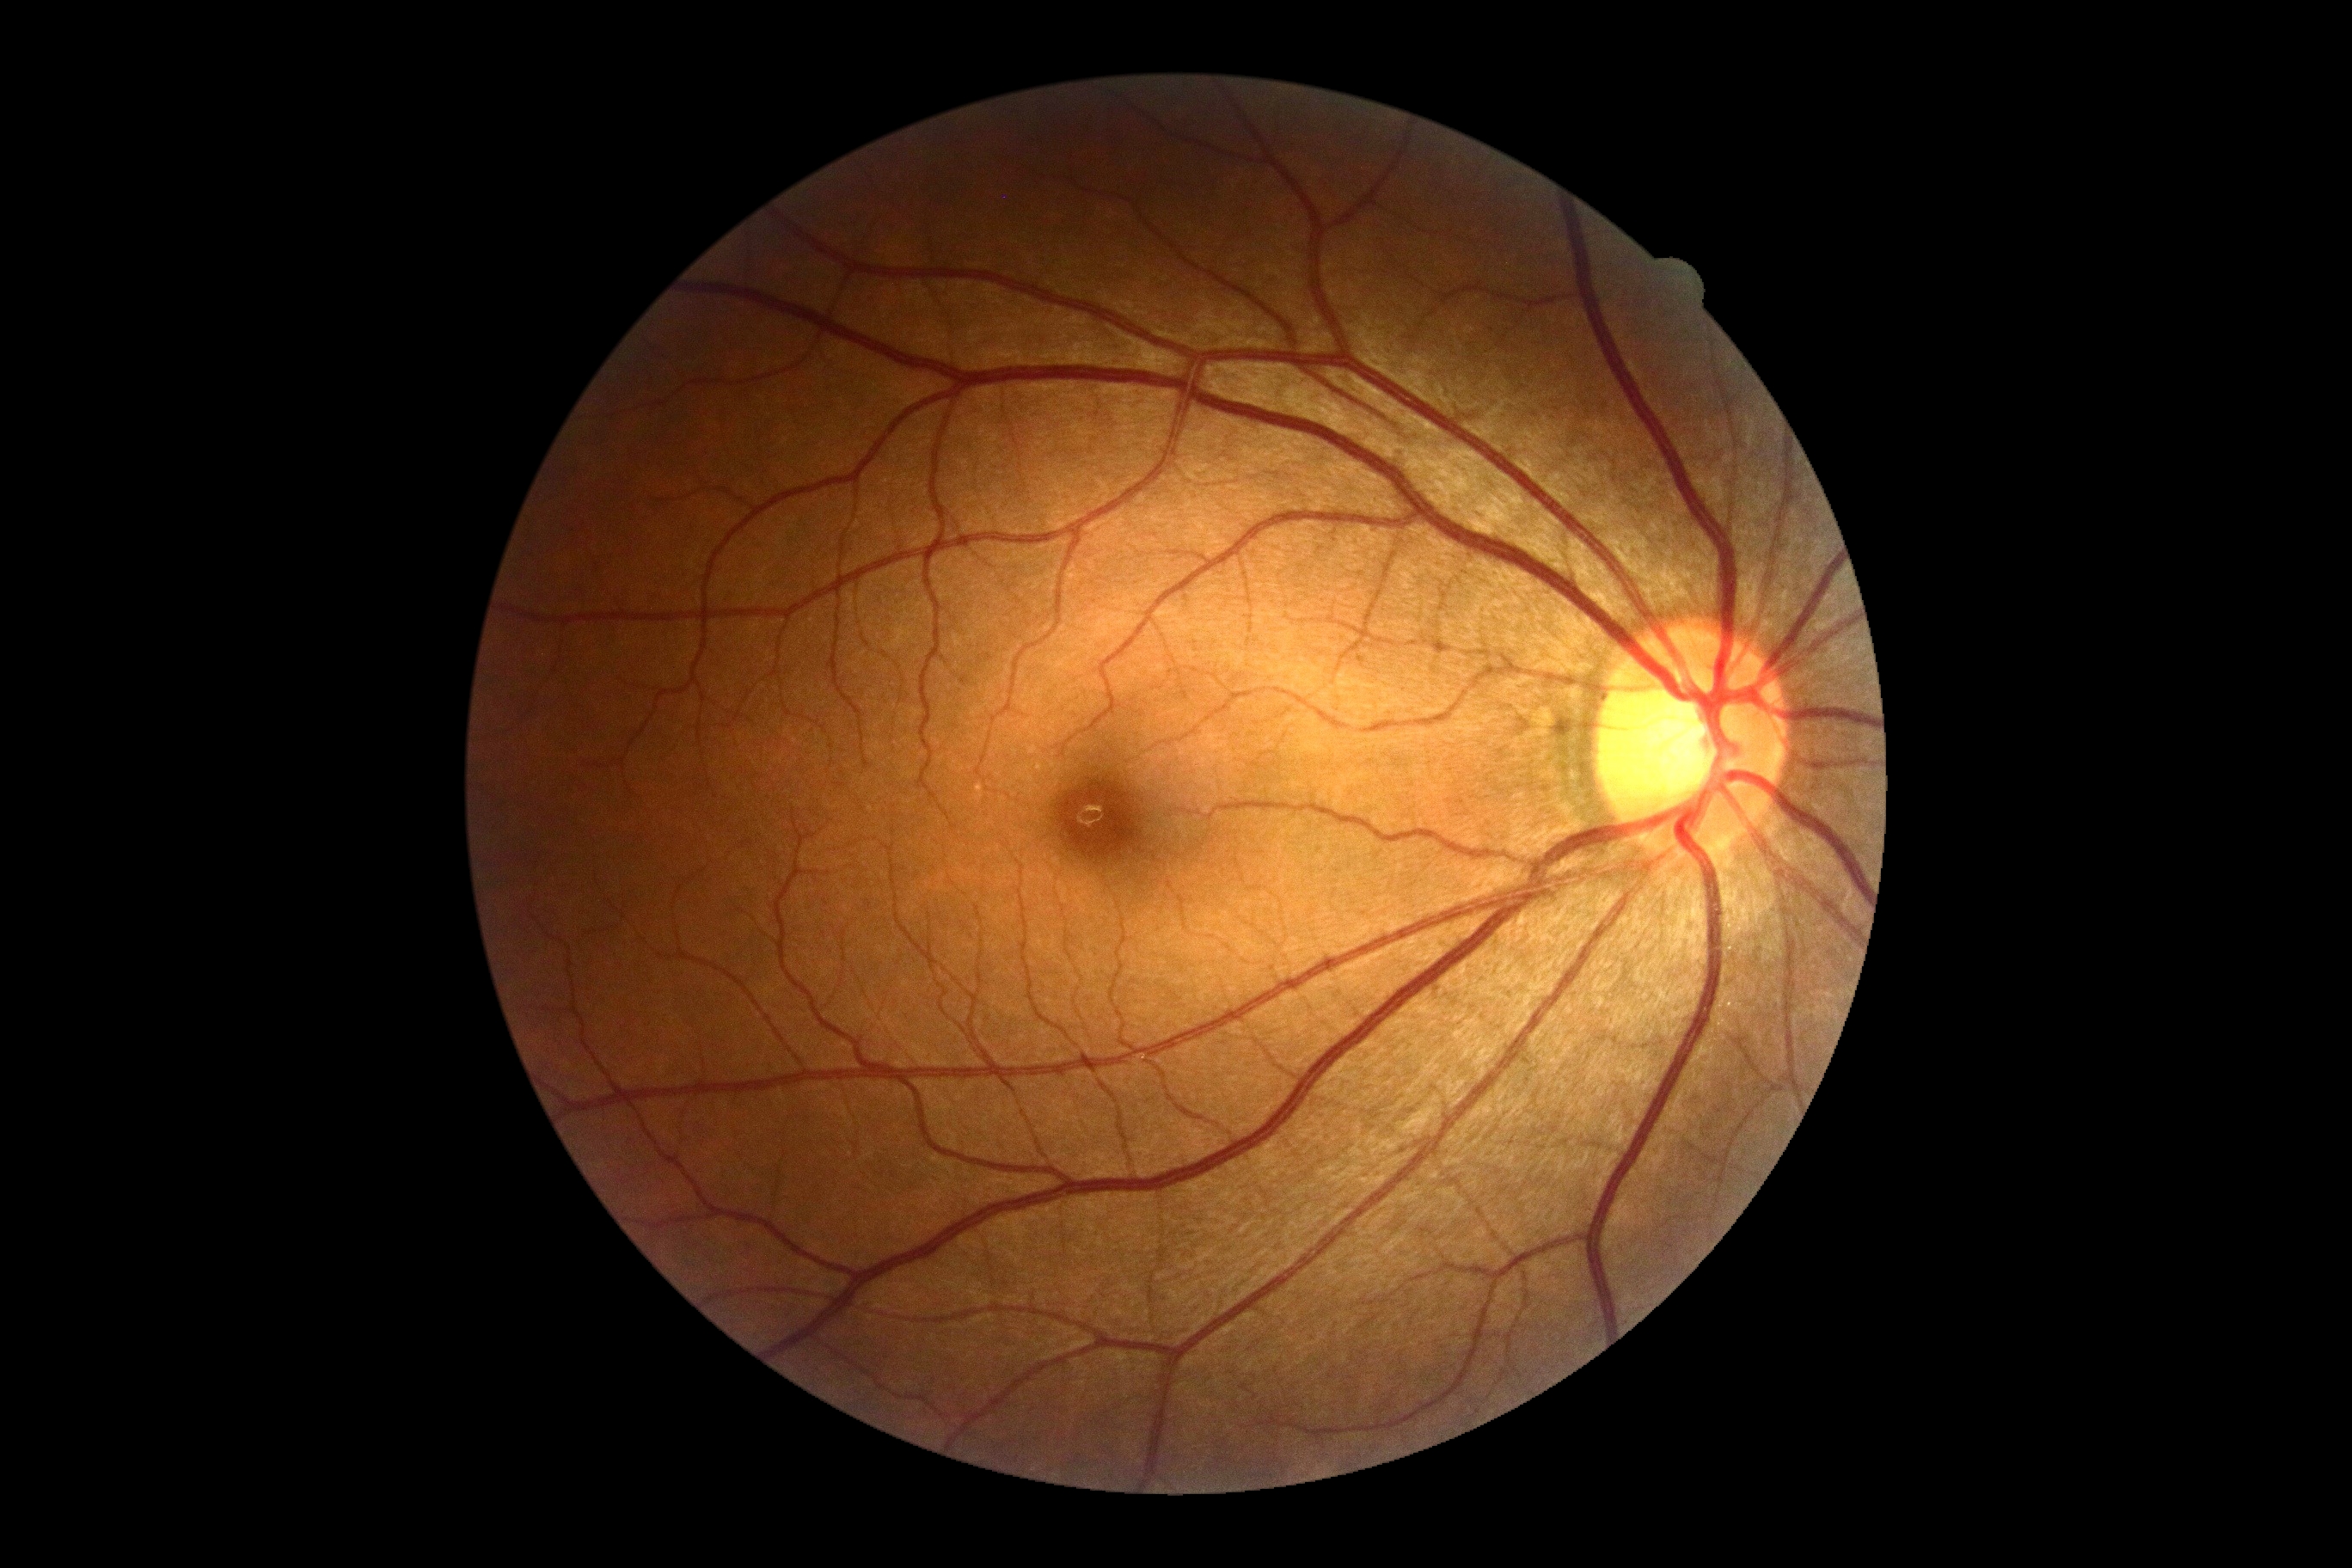
retinopathy grade = no apparent retinopathy (0), DR impression = no apparent DR.